Camera: Forus 3Nethra fundus camera; CFP
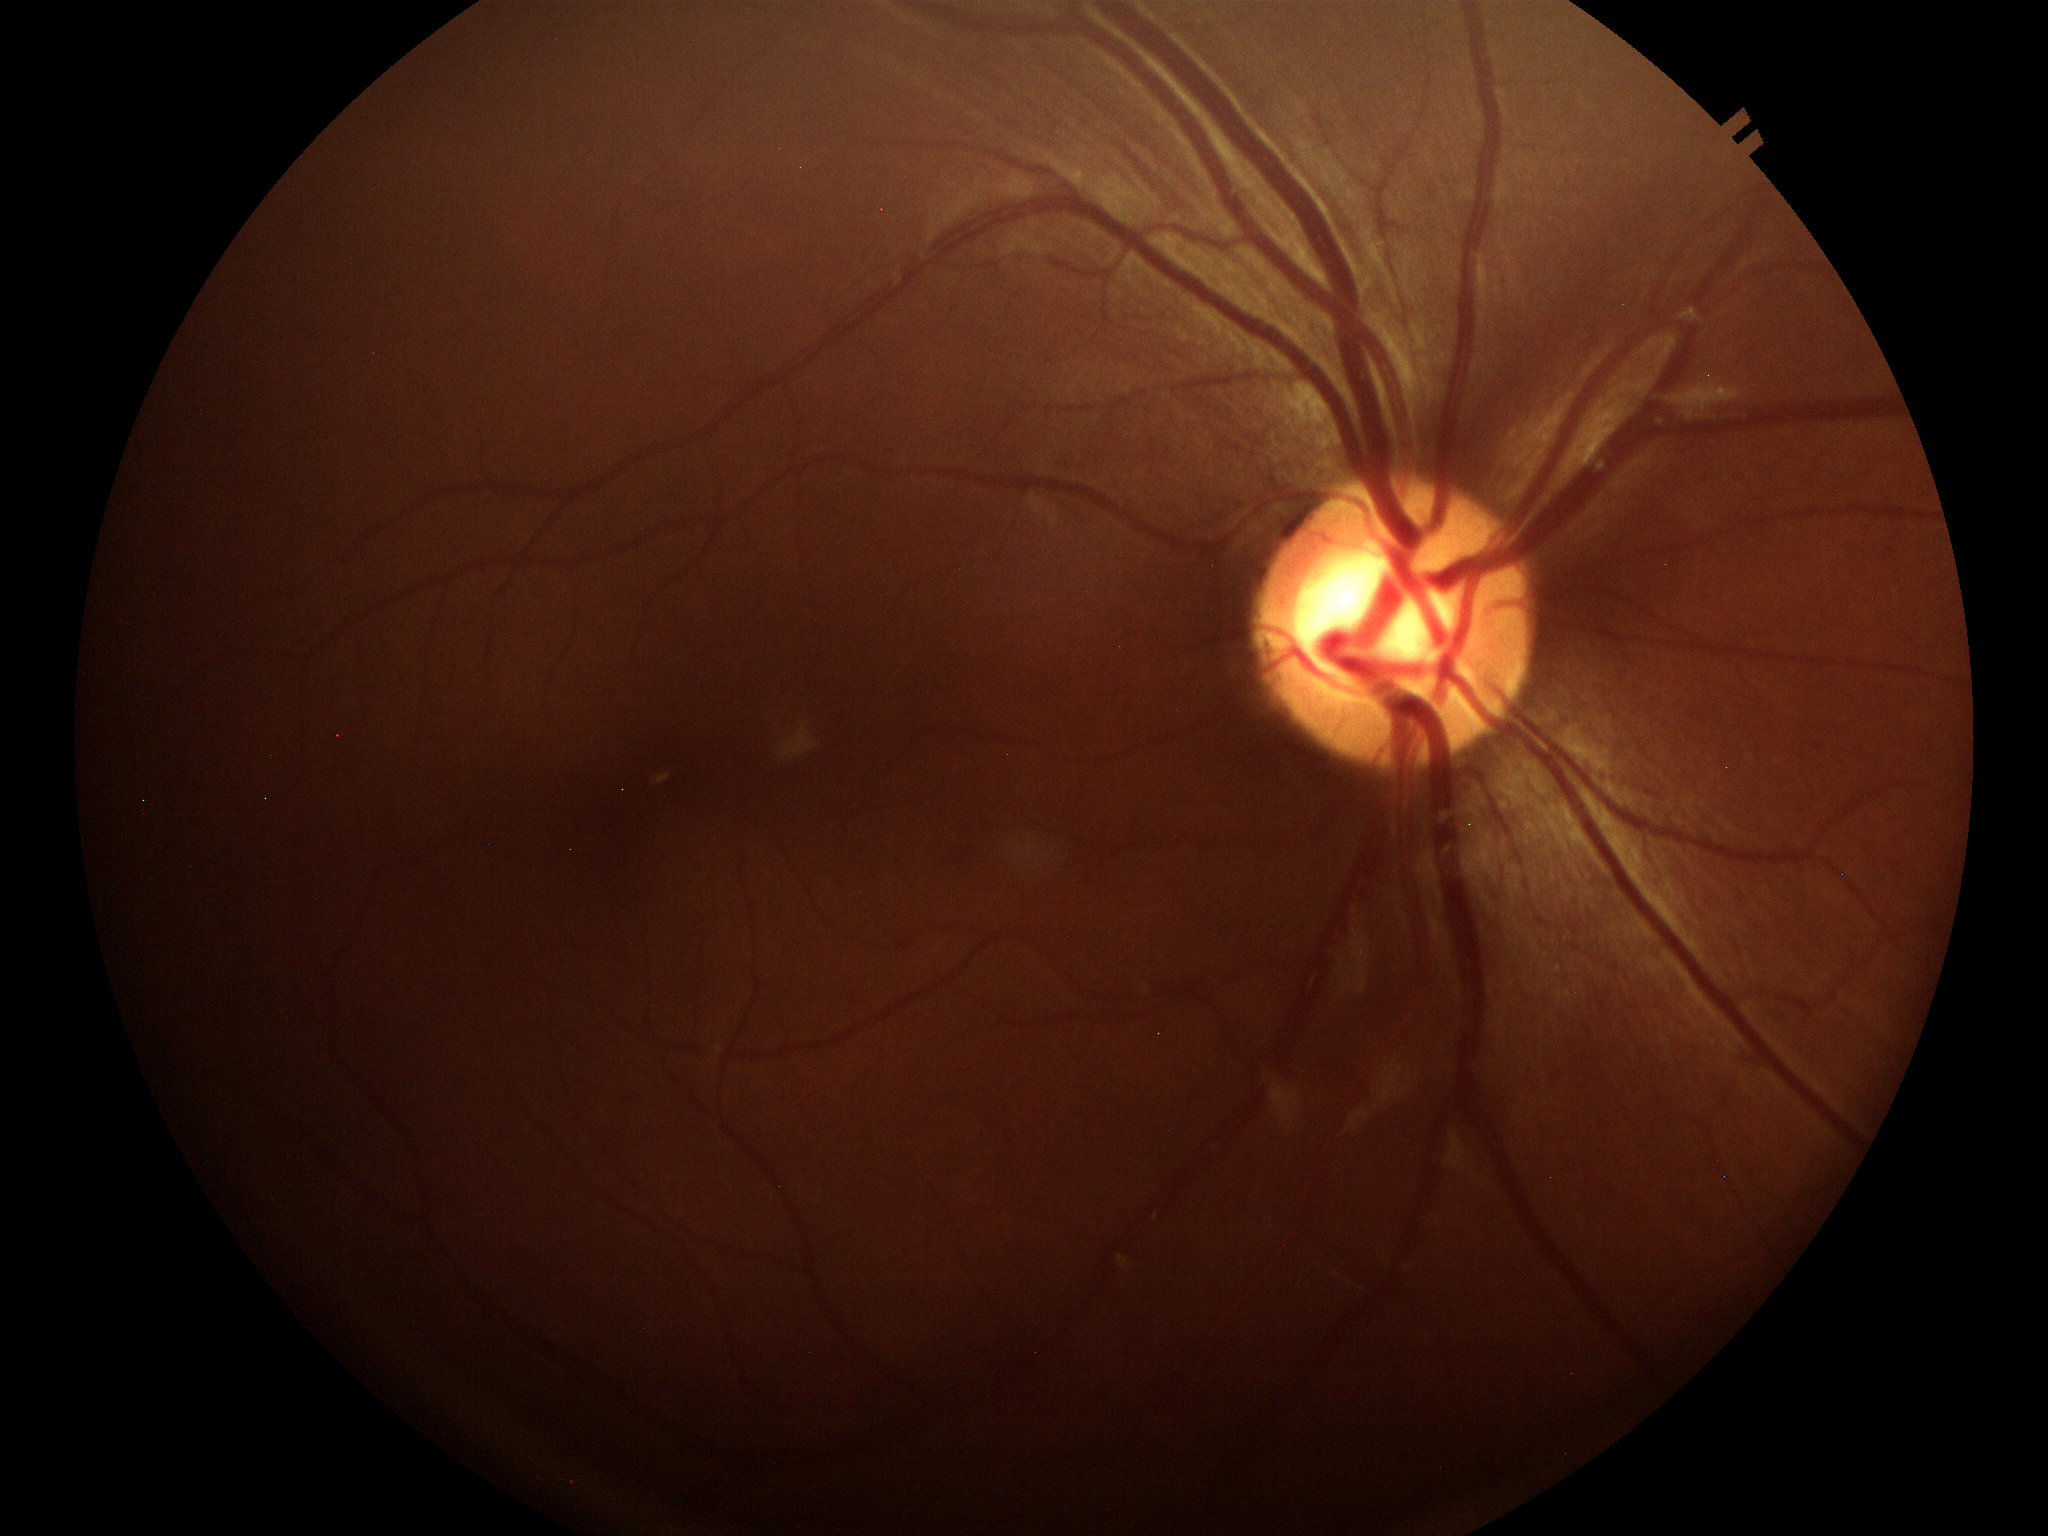 Glaucoma evaluation: not suspect. Vertical cup-disc ratio (VCDR): 0.57.